Posterior pole photograph · graded on the modified Davis scale:
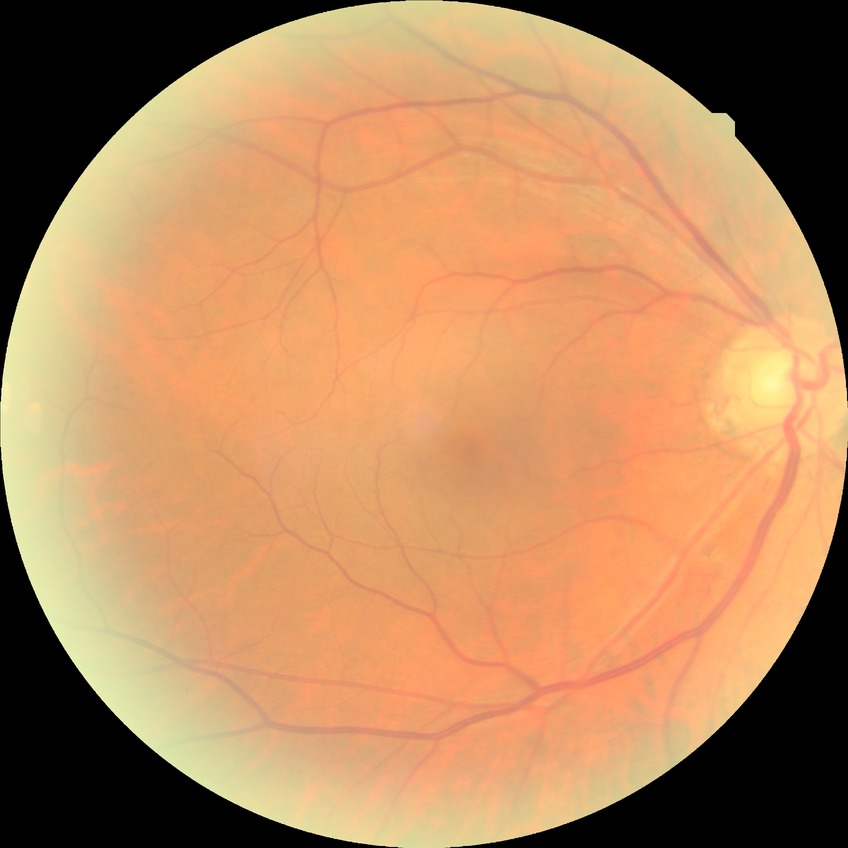
Diabetic retinopathy (DR): NDR (no diabetic retinopathy).